Graded on the modified Davis scale · retinal fundus photograph · 45° field of view — 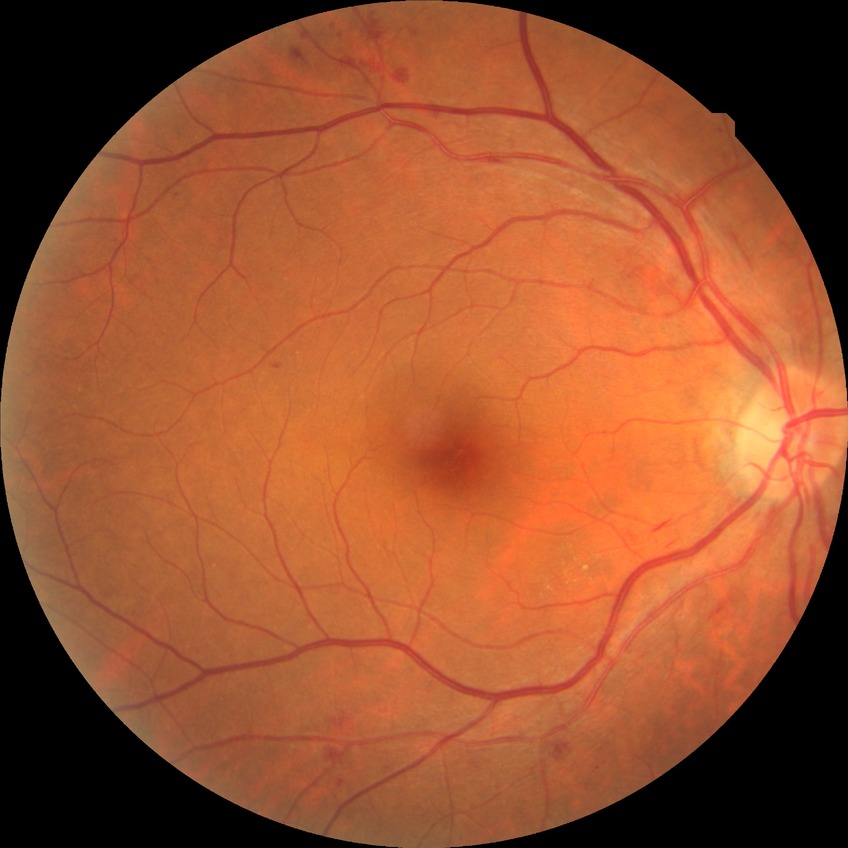

davis_grade: SDR (simple diabetic retinopathy)